848x848, 45 degree fundus photograph, color fundus photograph, acquired with a NIDEK AFC-230: 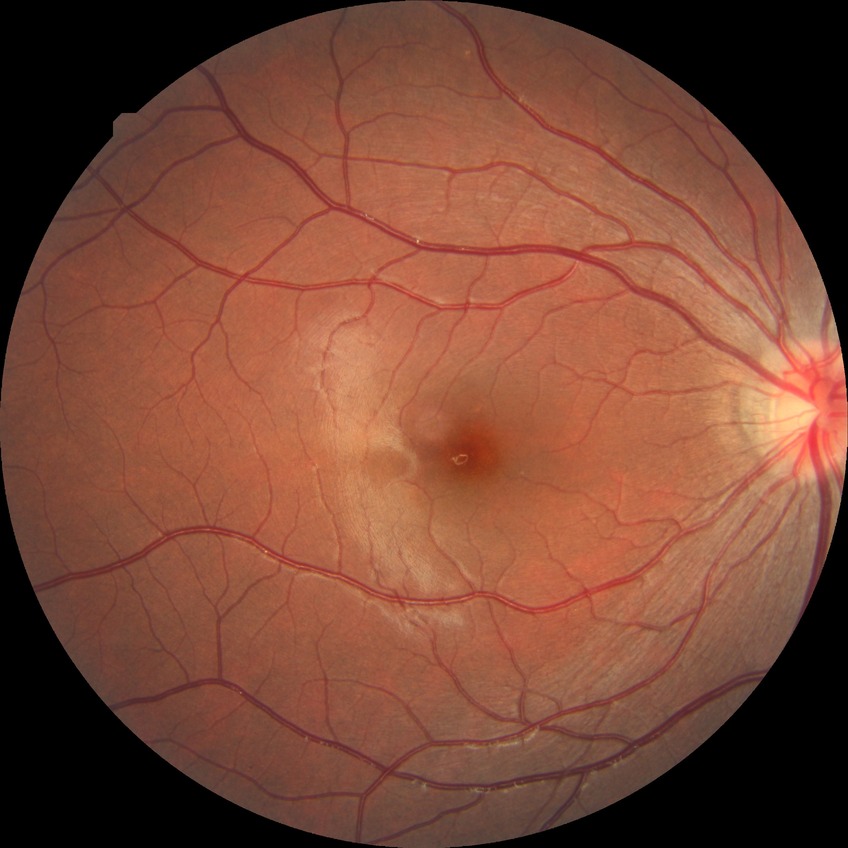 diabetic retinopathy (DR): NDR (no diabetic retinopathy).